Pediatric retinal photograph (wide-field) · acquired on the Phoenix ICON:
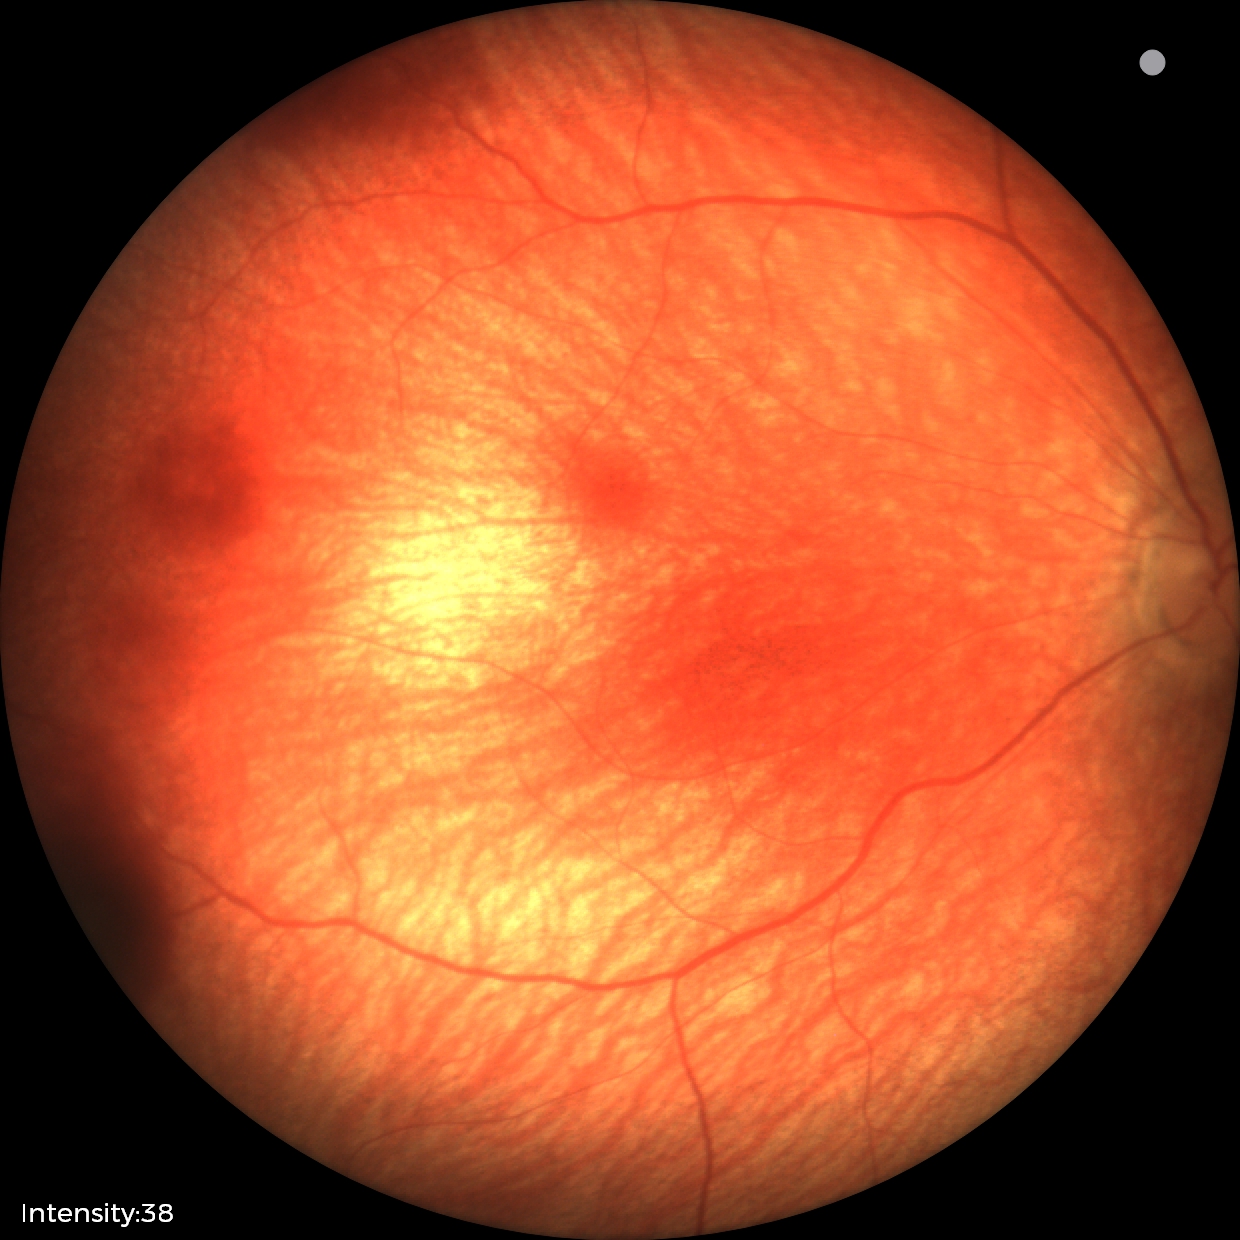 Examination diagnosed as retinal hemorrhages.